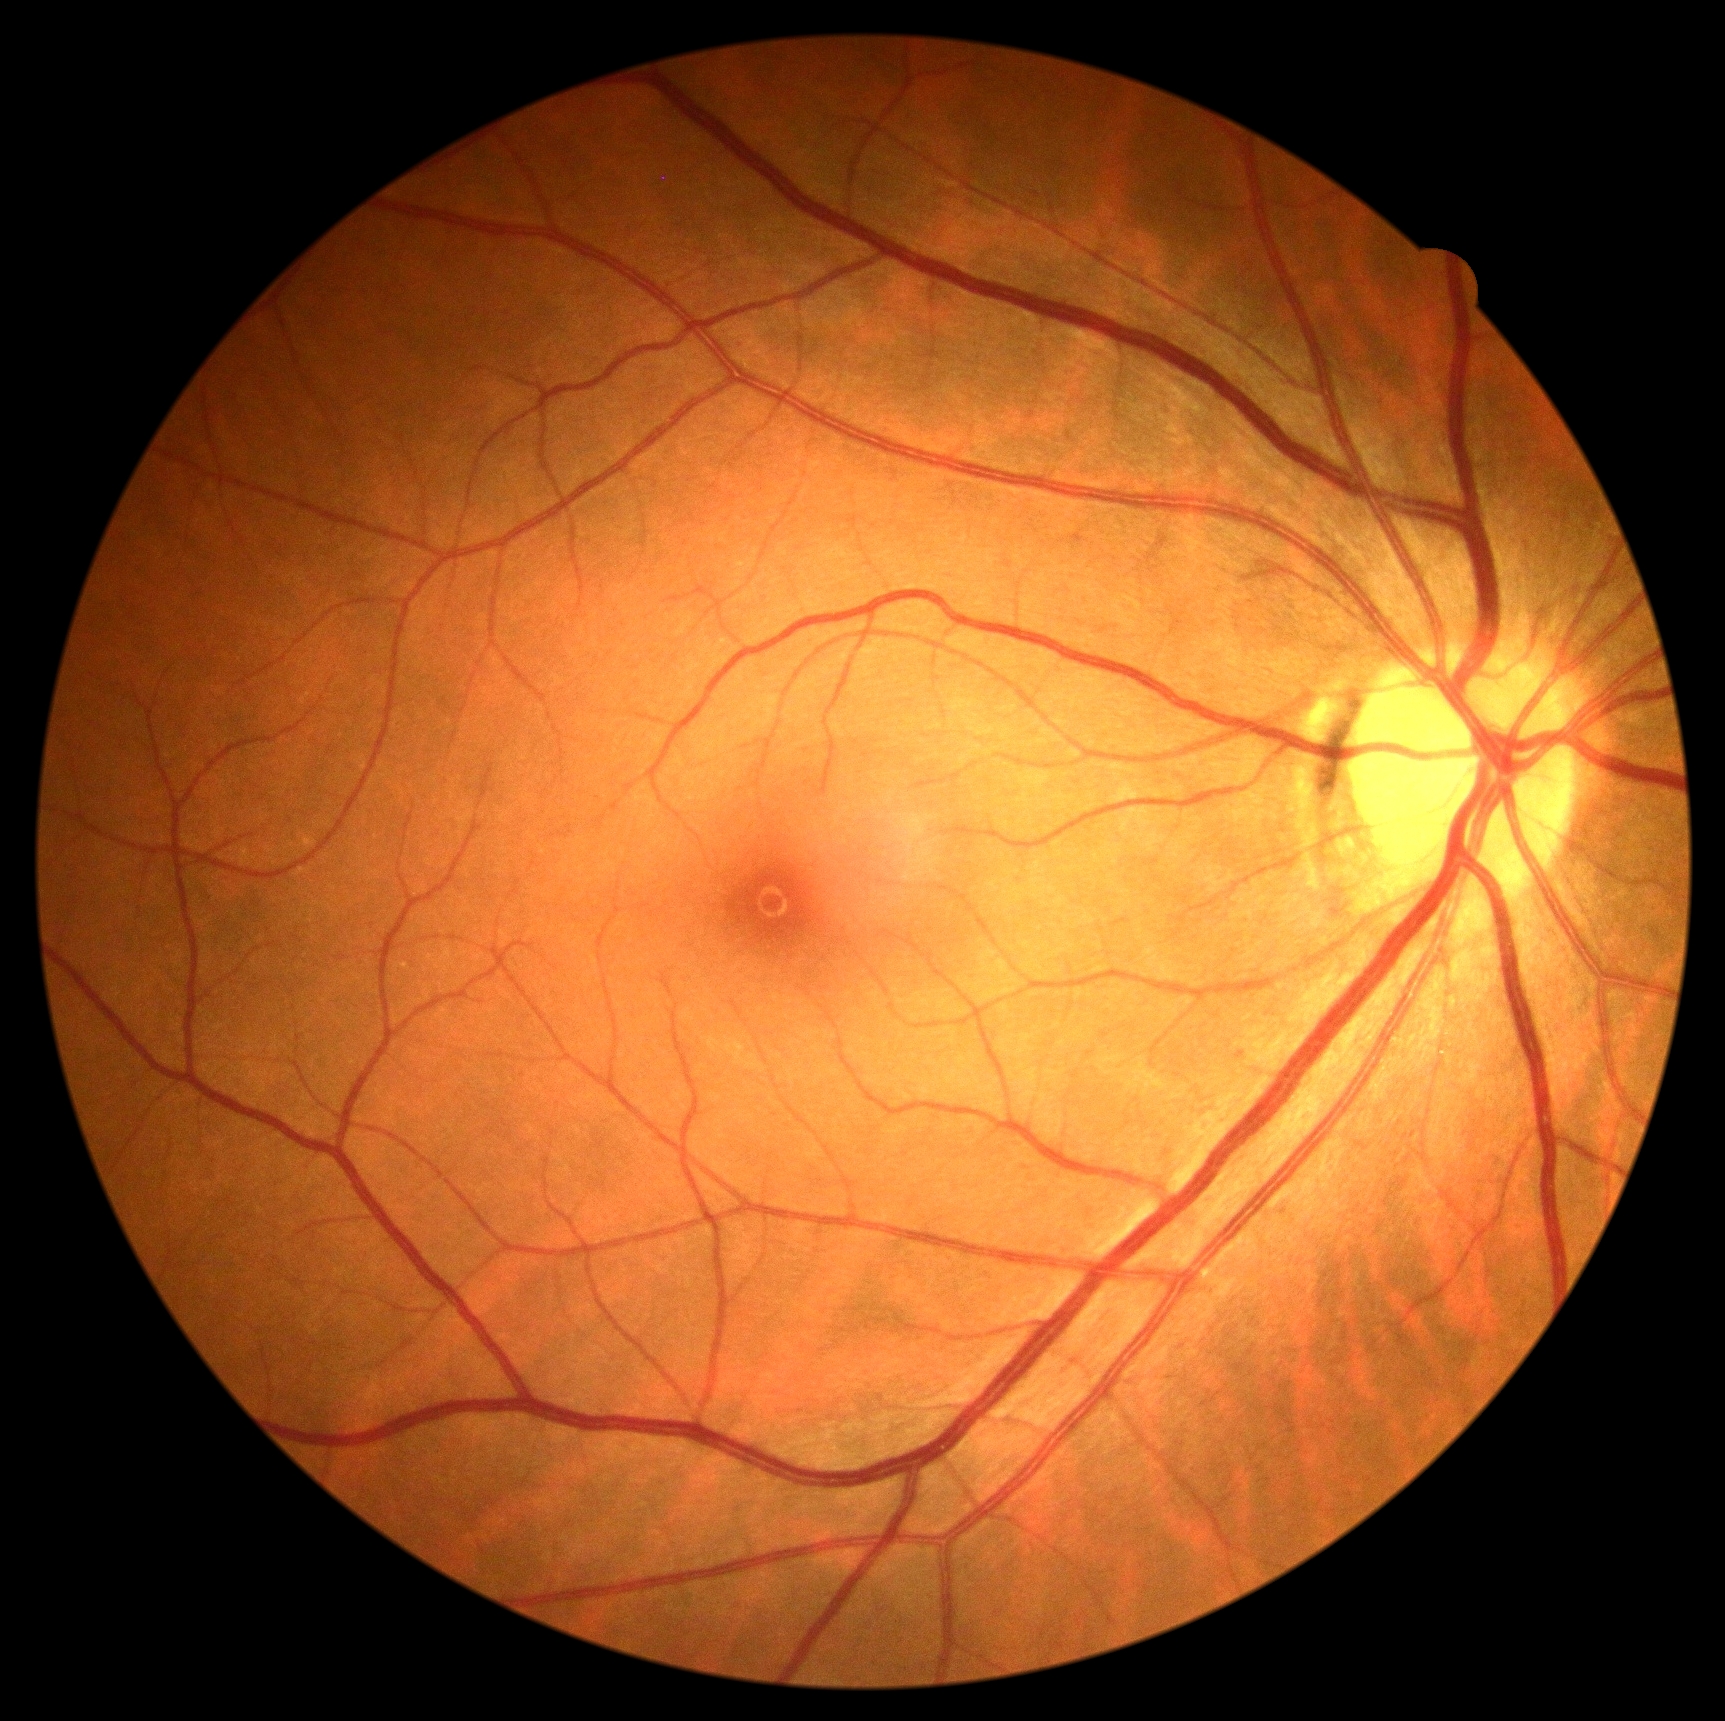
diabetic retinopathy = grade 0 (no apparent retinopathy) — no visible signs of diabetic retinopathy
DR impression = negative for DR